CFP.
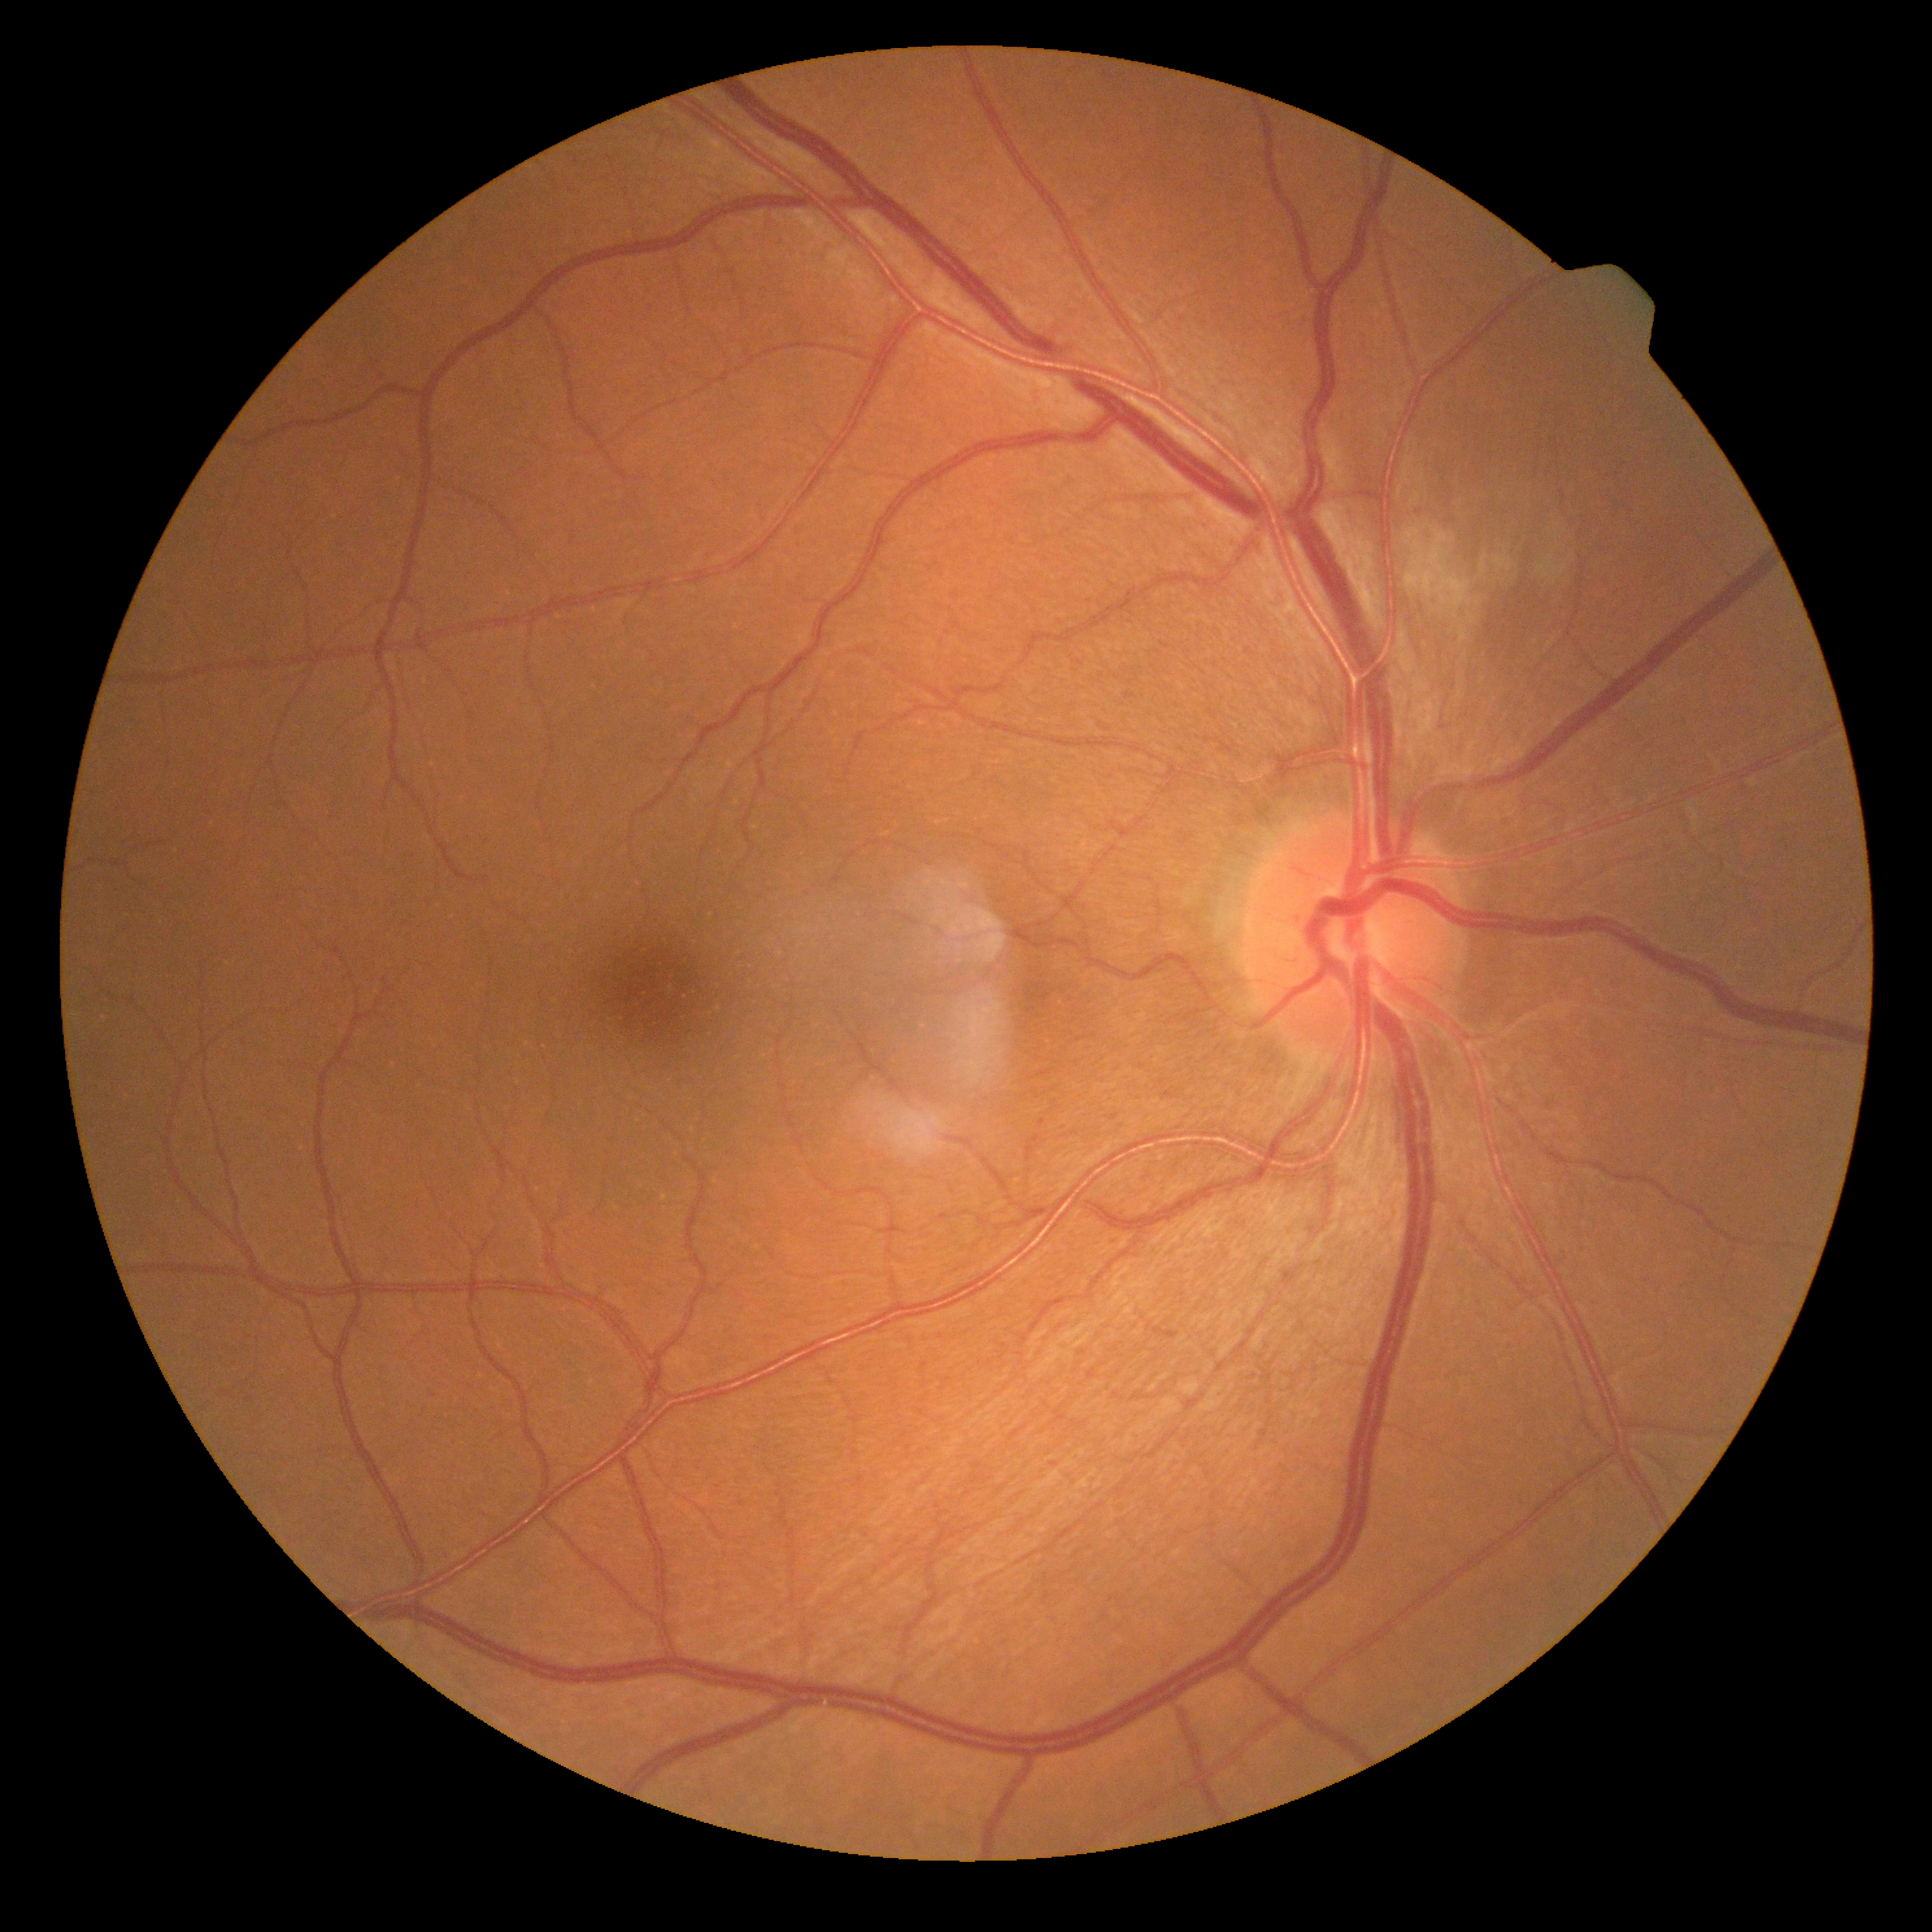

Diabetic retinopathy (DR): grade 2 (moderate NPDR).